1932 x 1932 pixels — 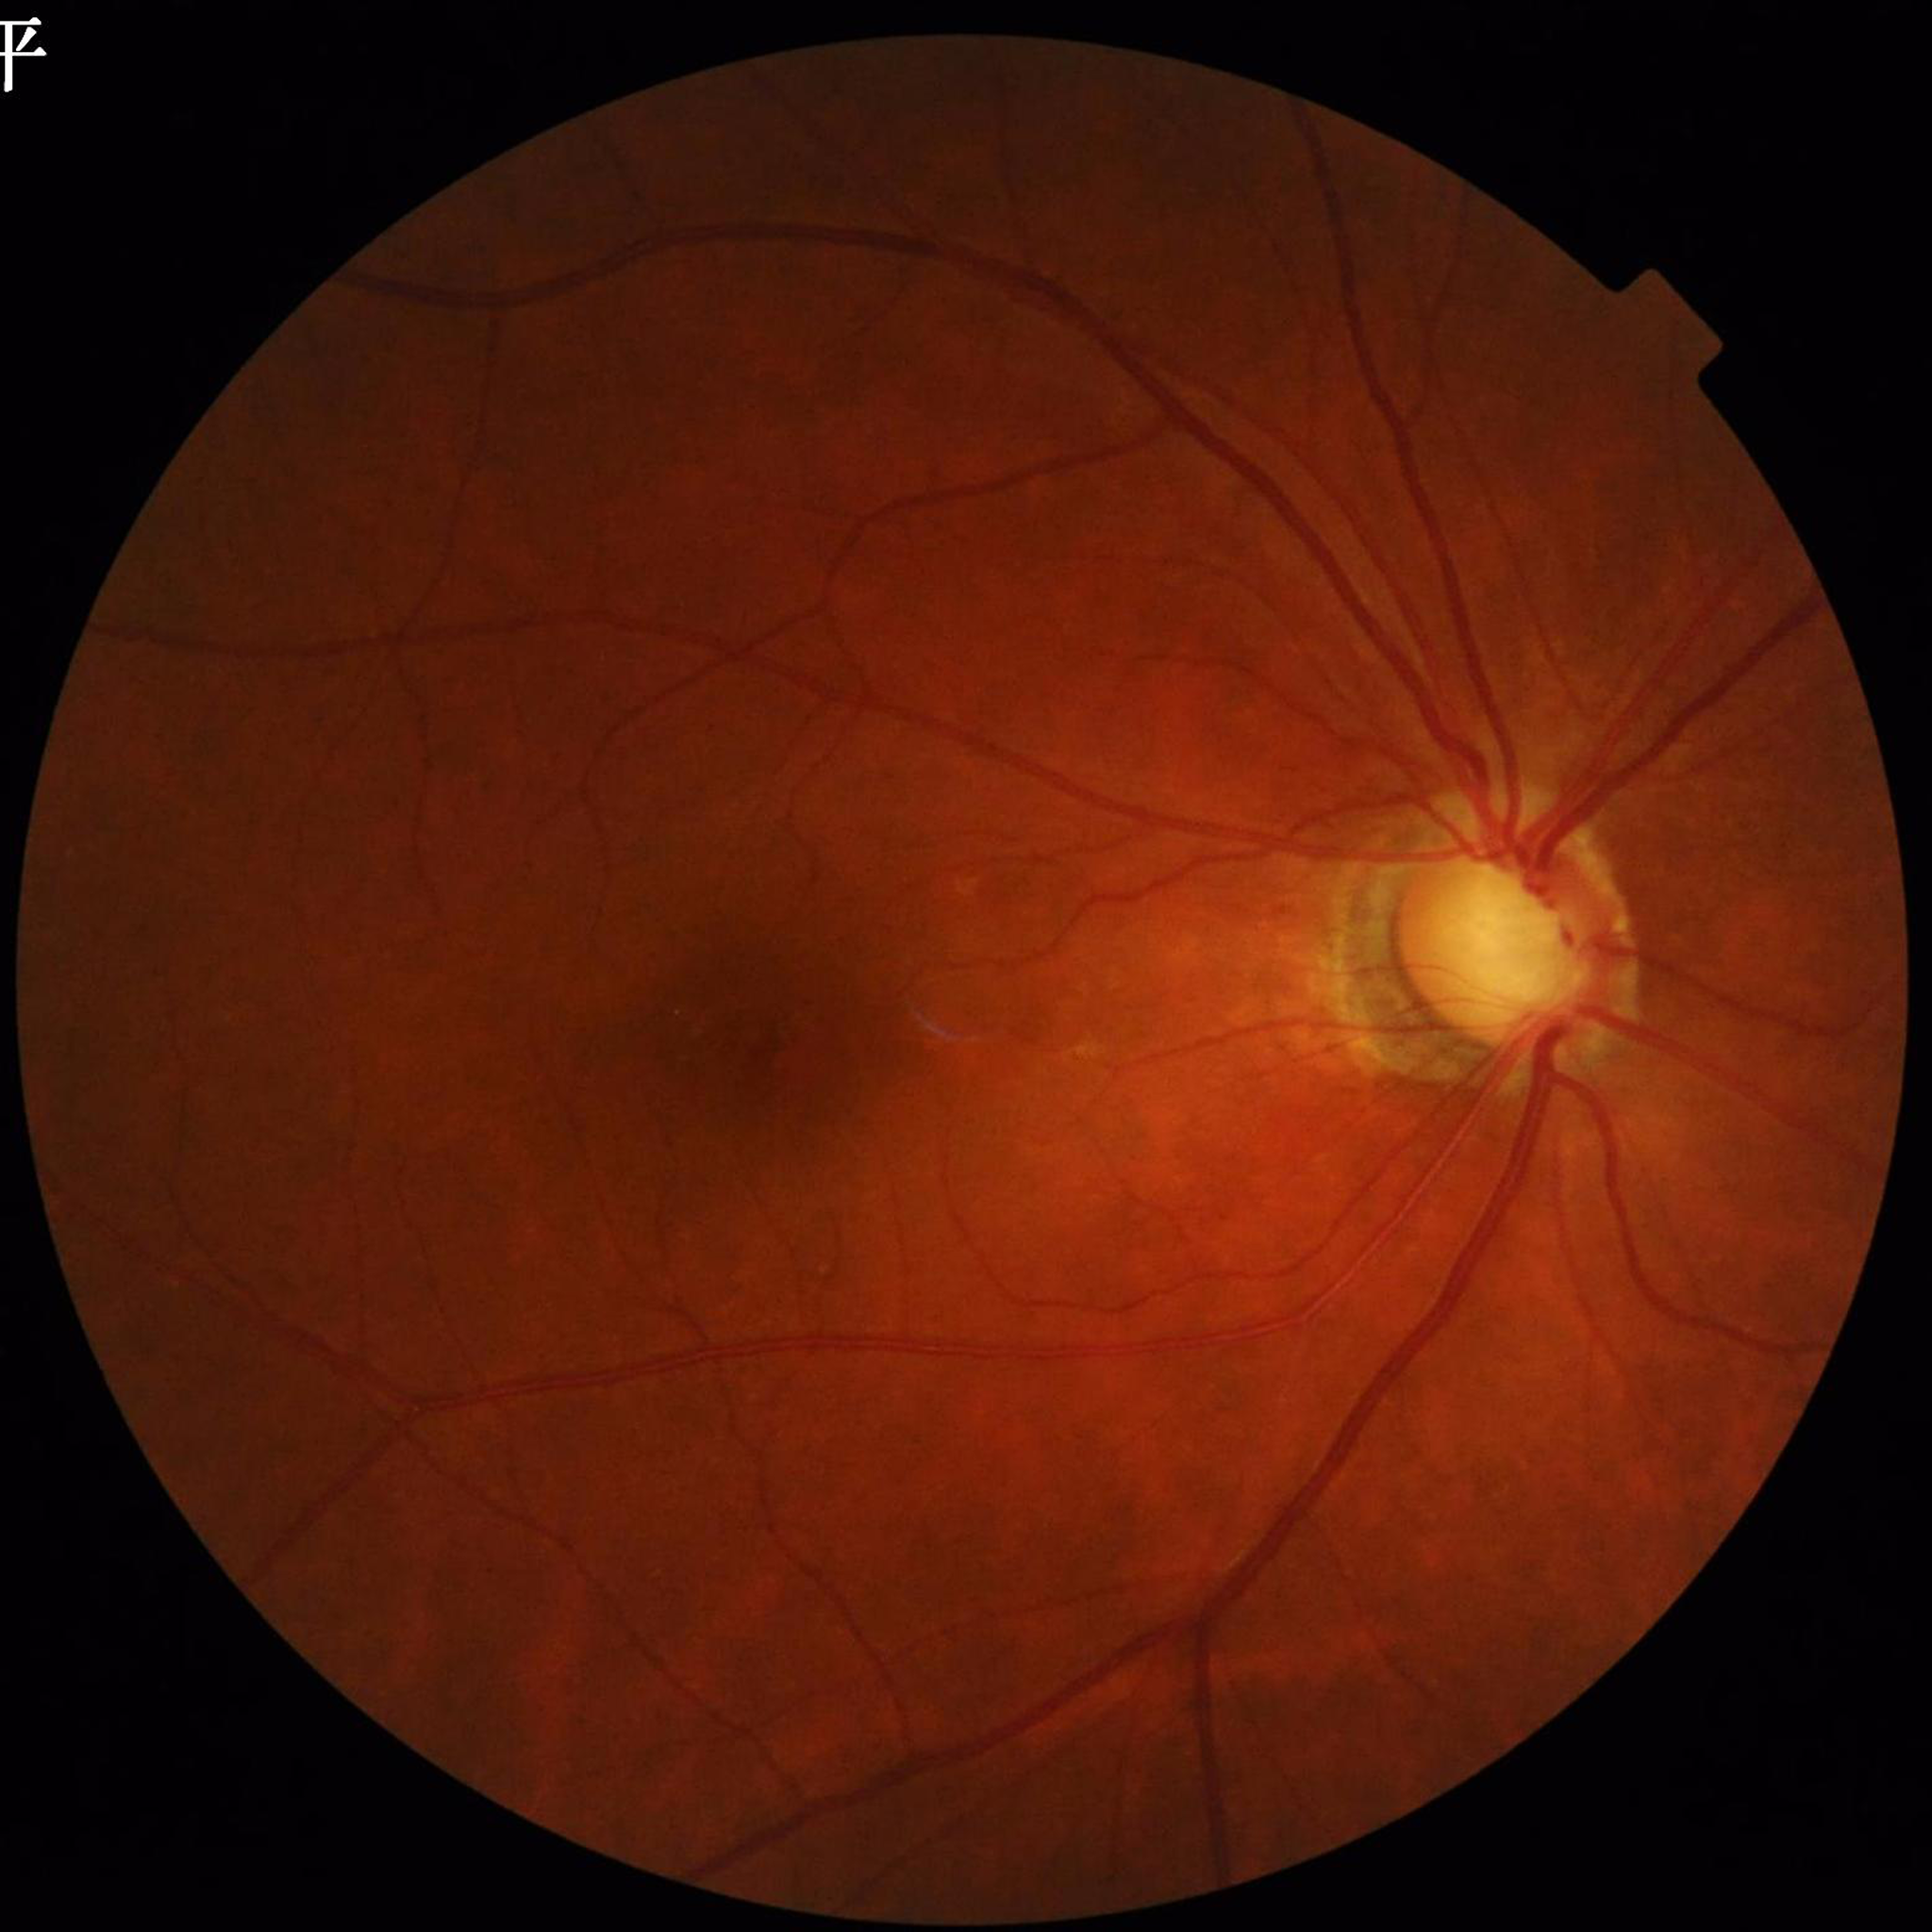 Photo quality: no concerns identified
Condition: glaucoma